45-degree field of view.
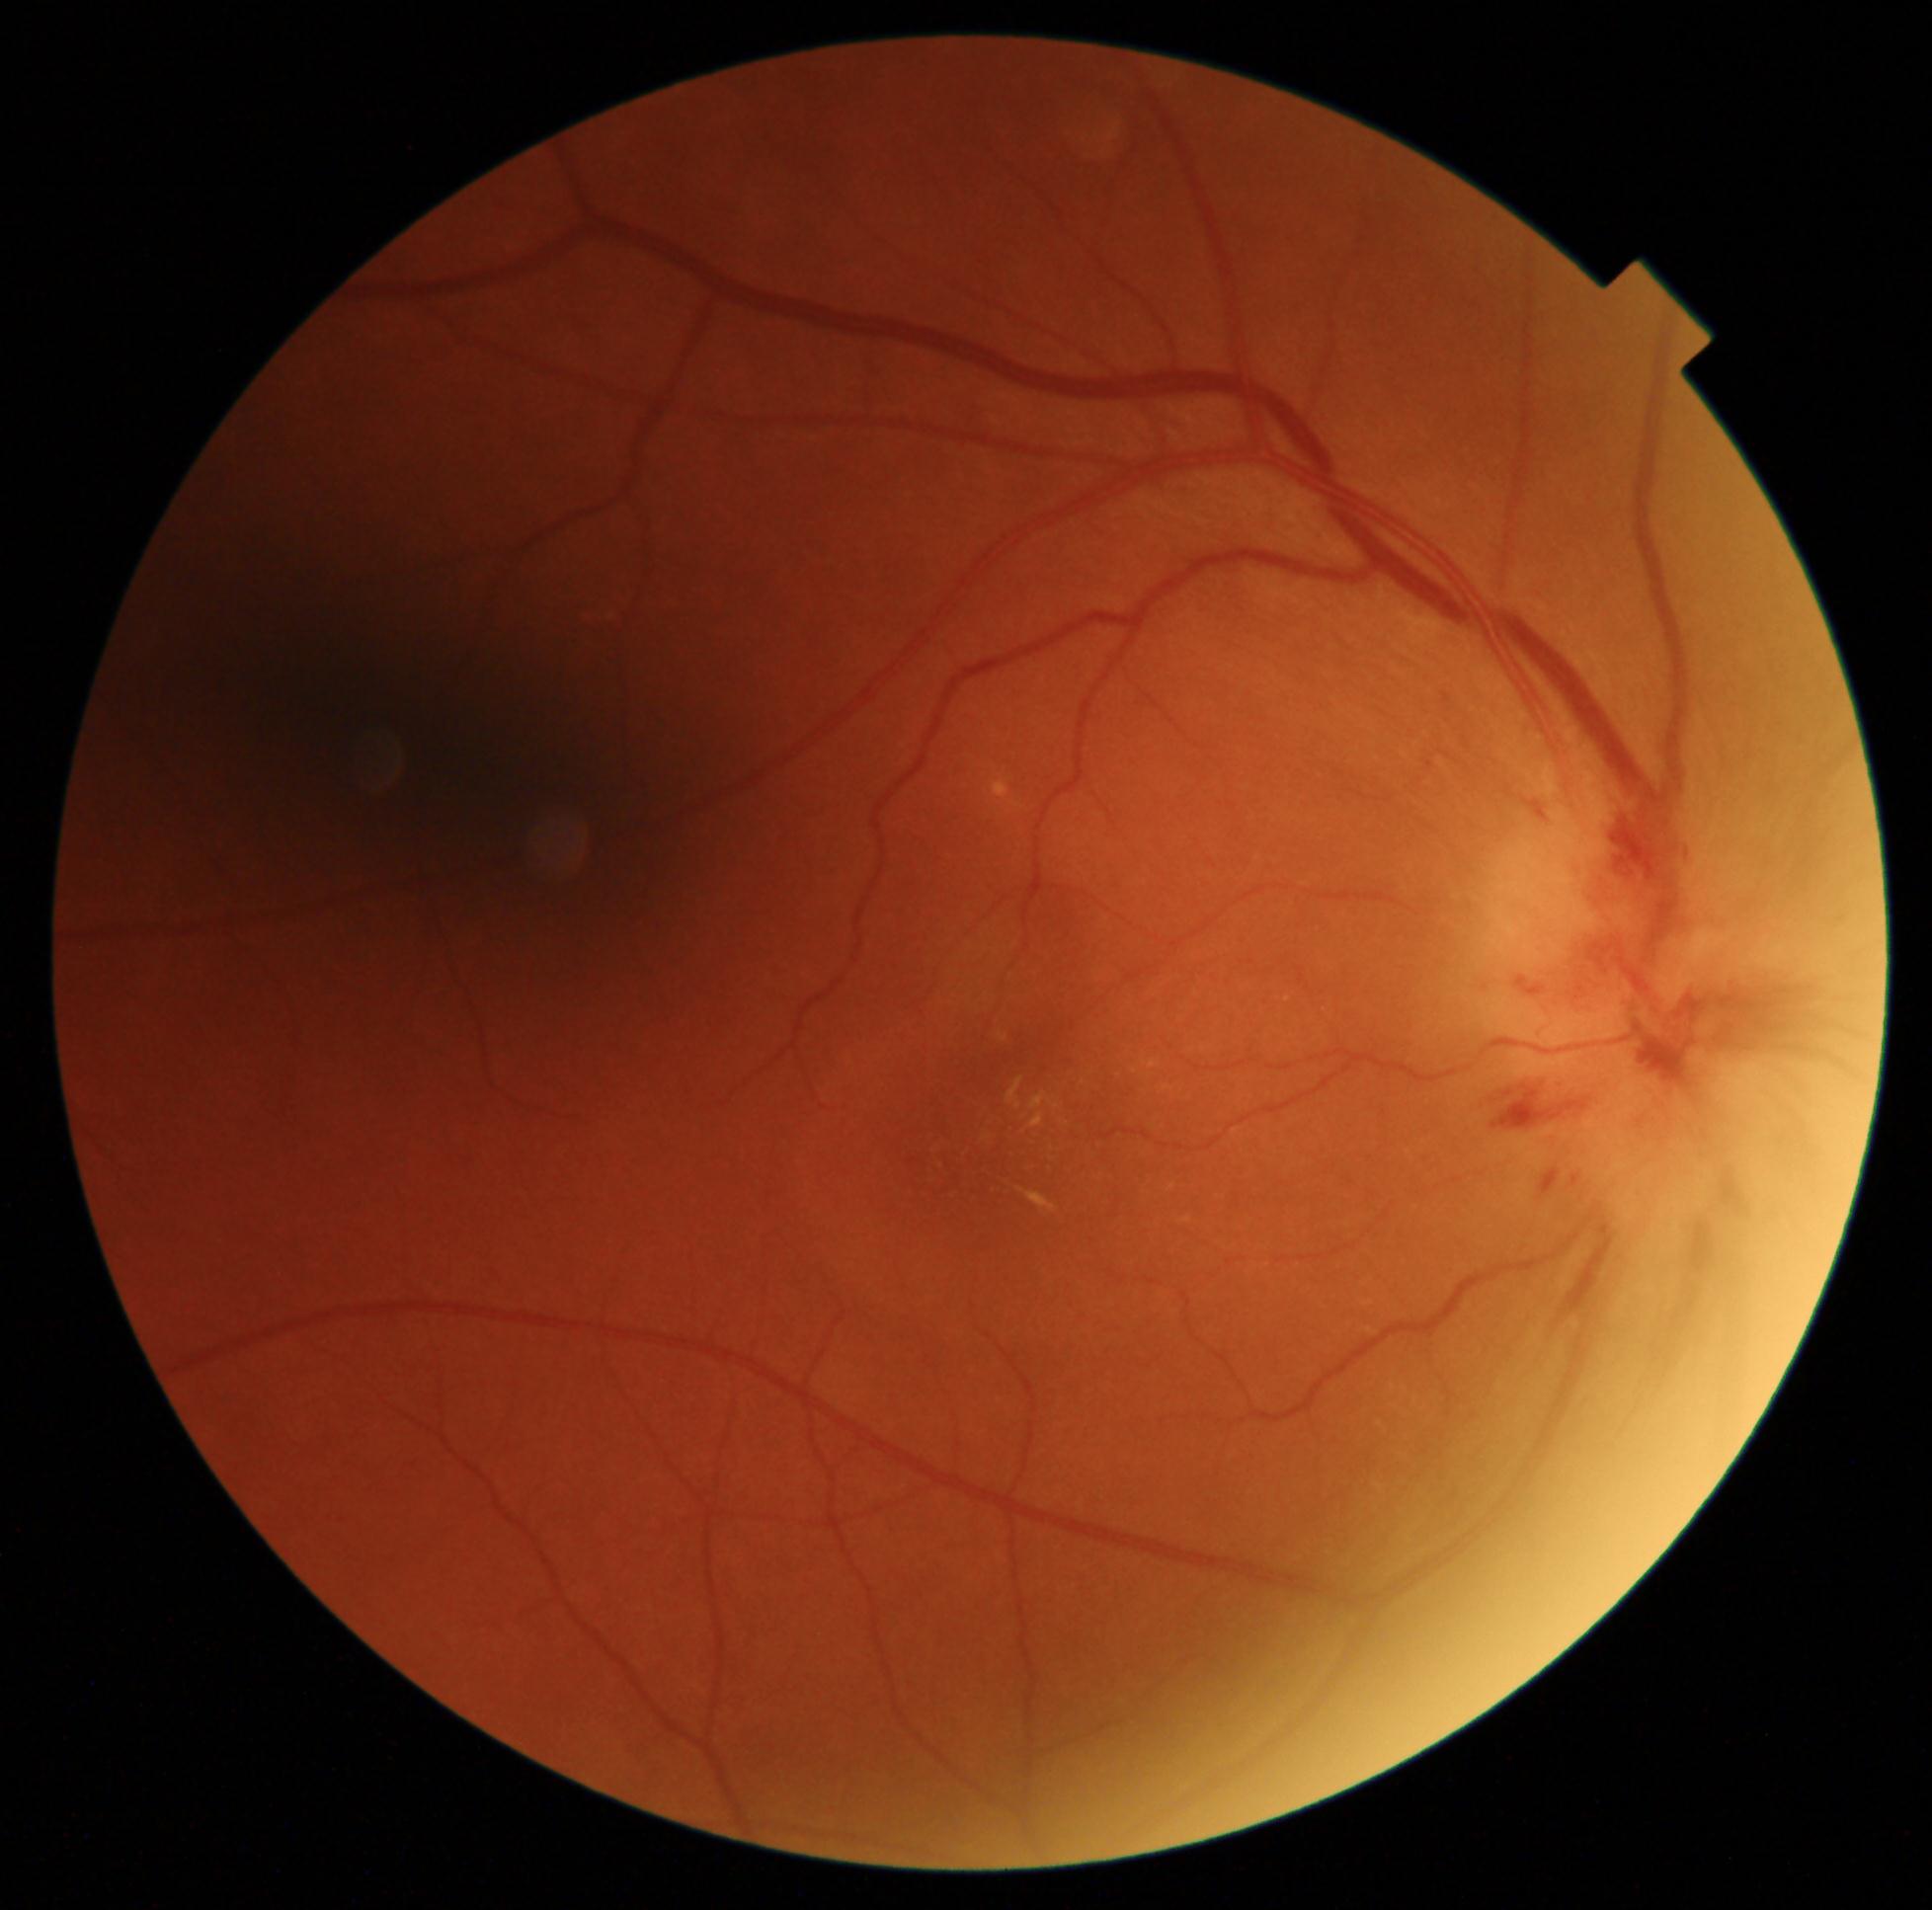
DR stage: grade 2 (moderate NPDR).